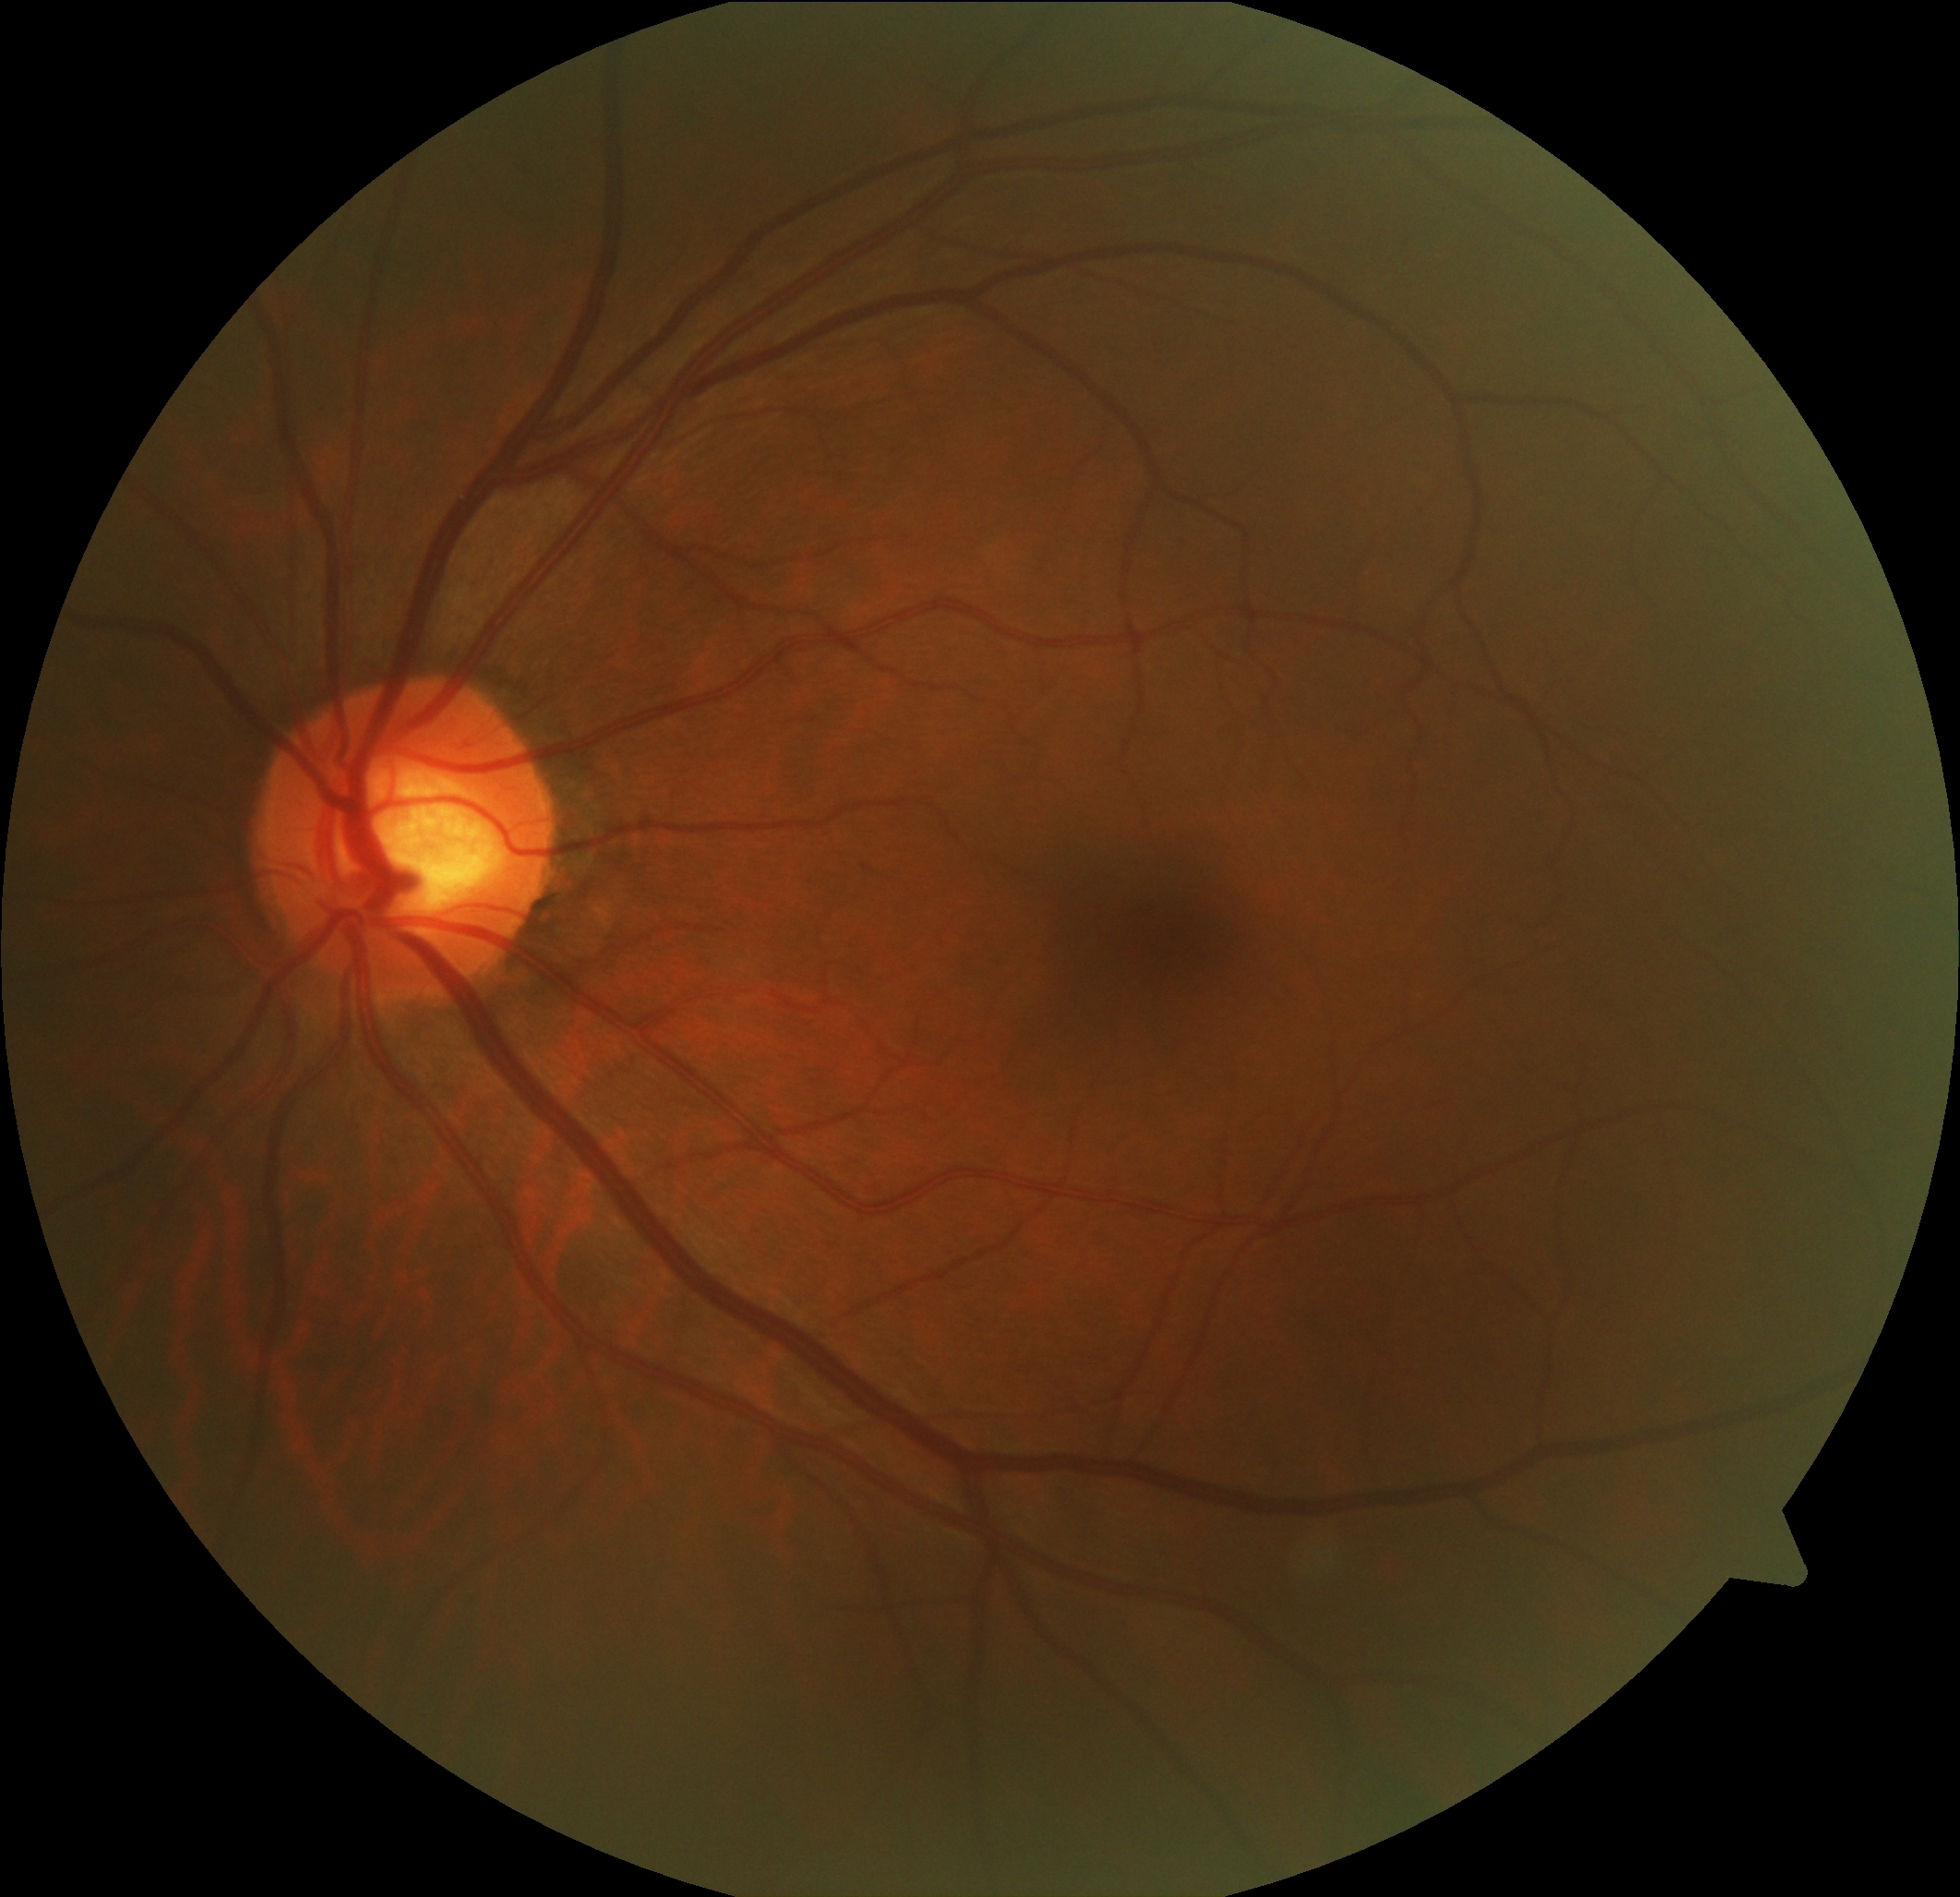
DR is 0.